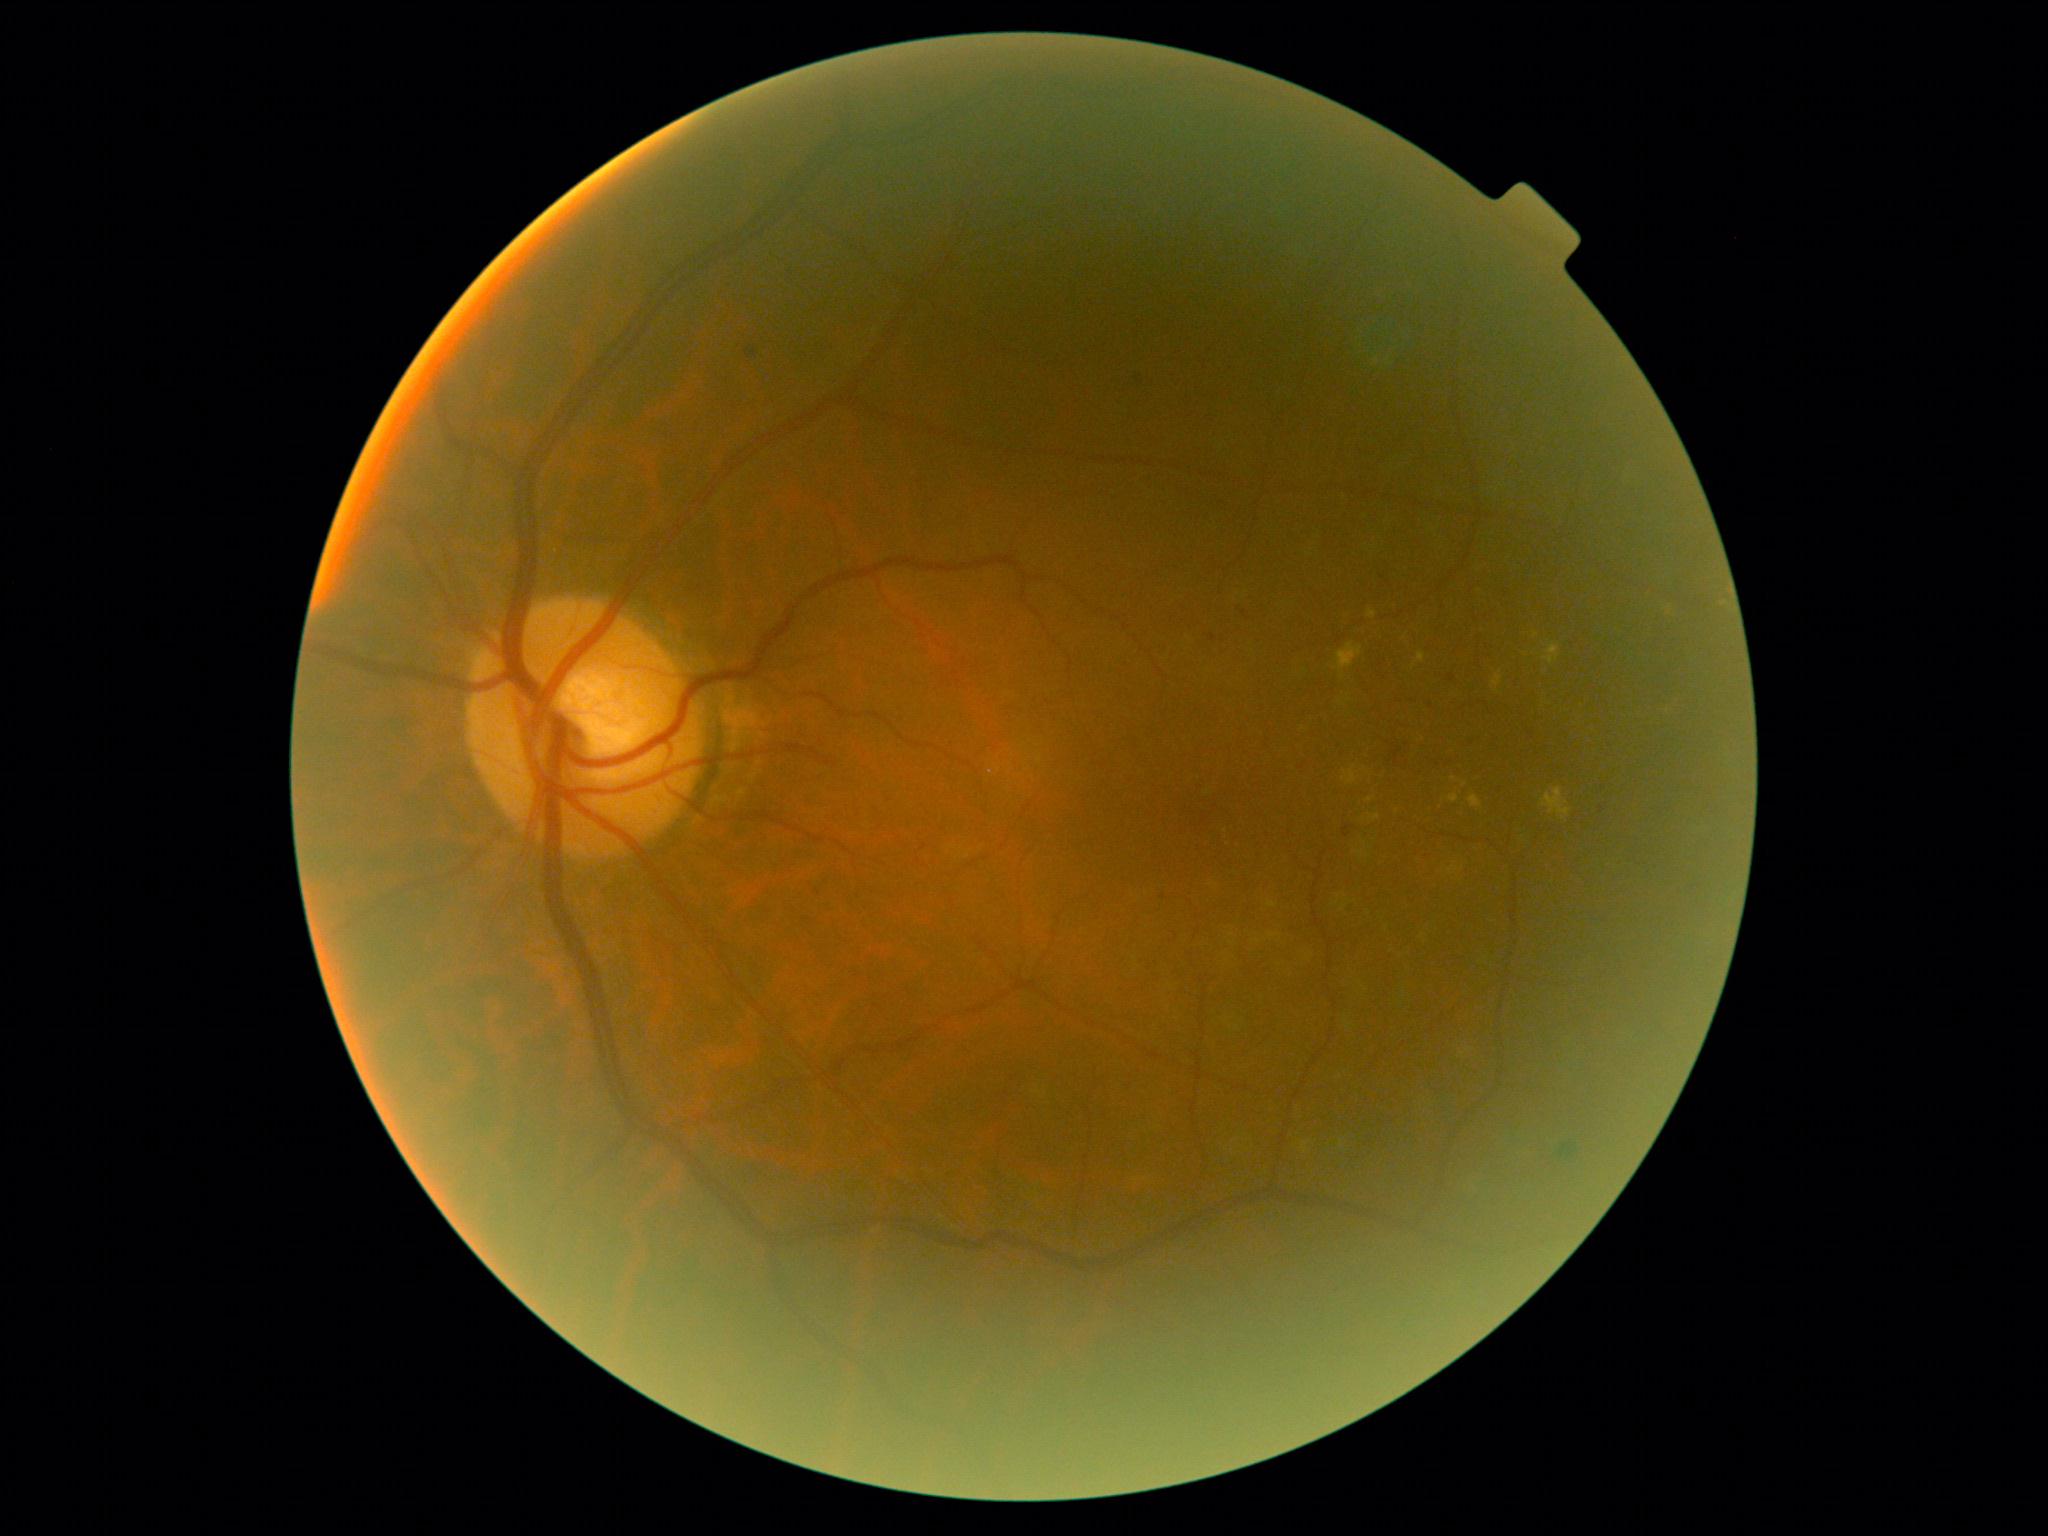
DR stage = grade 2 (moderate NPDR), DR class = non-proliferative diabetic retinopathy.